2048x1536, fundus photo.
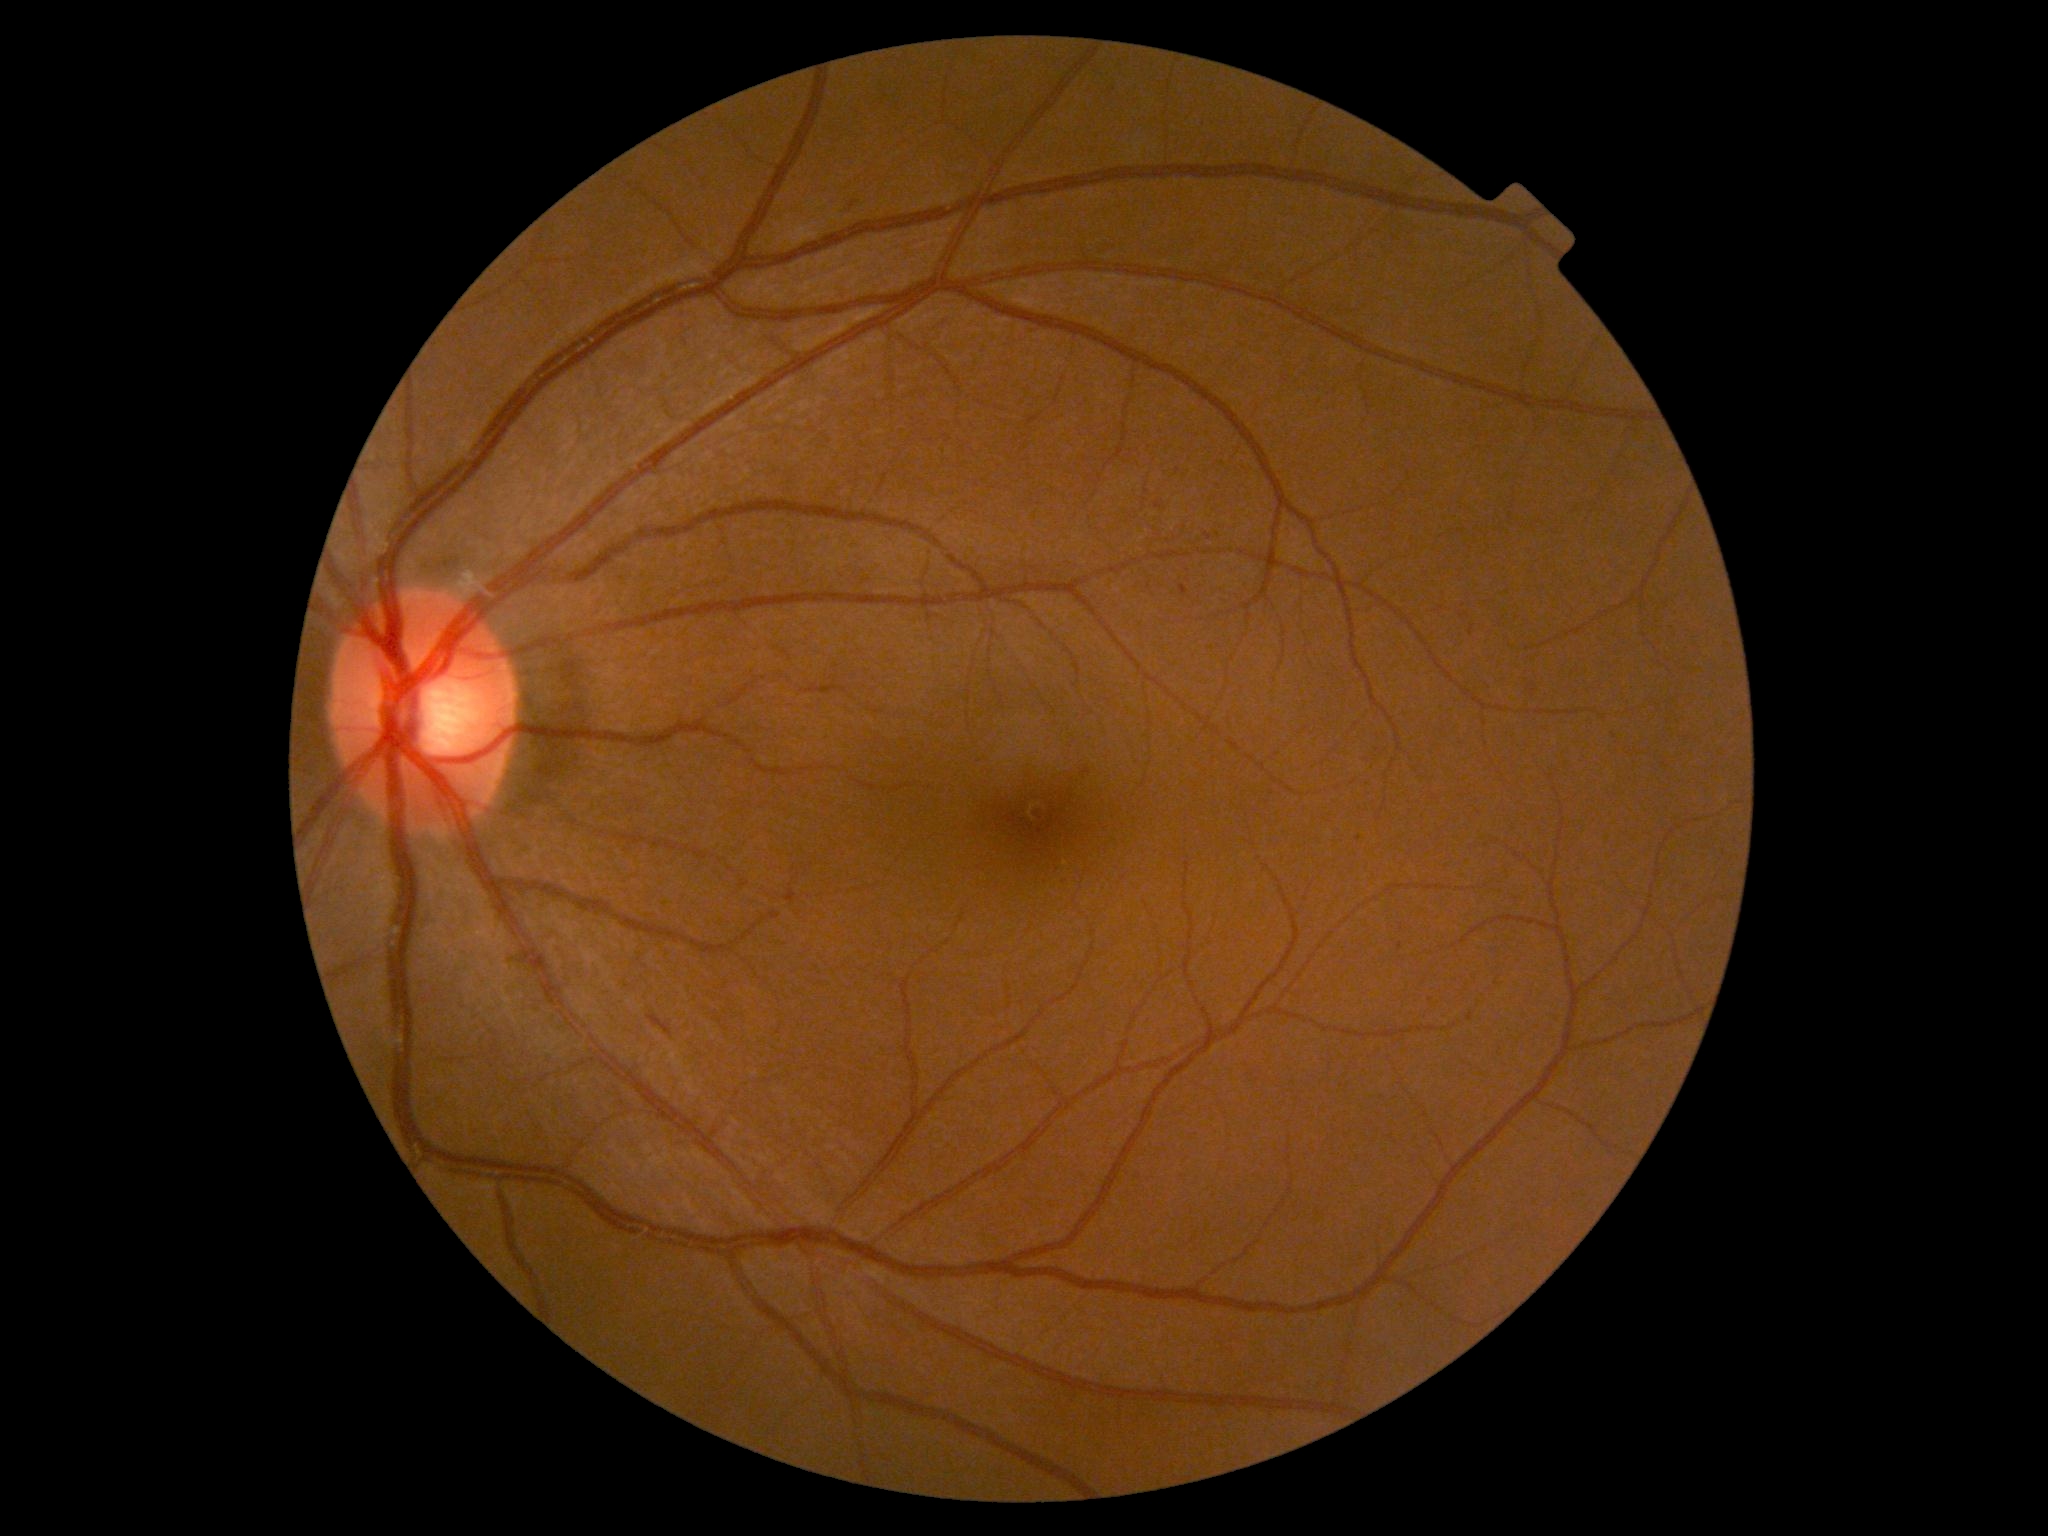
Diabetic retinopathy (DR): 1/4.